283x283, optic disc-centered crop from a color fundus photograph, 35° FOV before cropping: 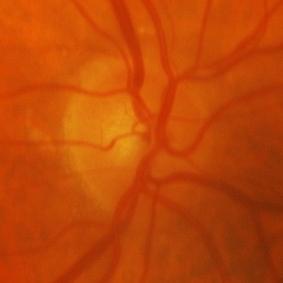

Glaucomatous changes.